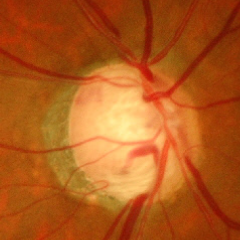

Q: Does this eye have glaucoma?
A: Severe glaucomatous damage. Diagnostic criteria: near-total cupping of the optic nerve head, with or without severe visual field loss within the central 10 degrees of fixation.